640 x 480 pixels. Pediatric wide-field fundus photograph.
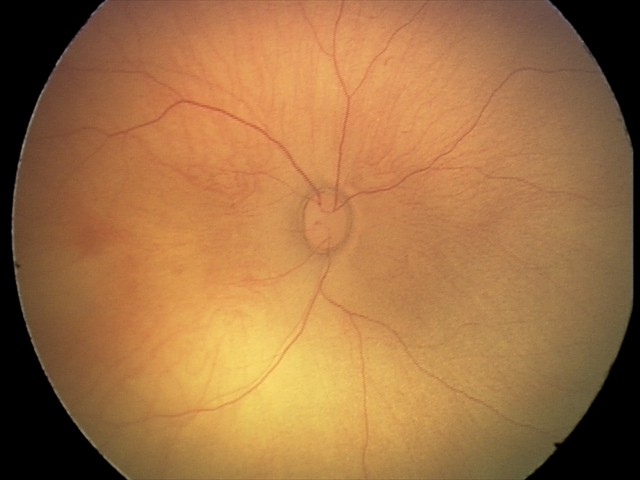
Diagnosis from this screening exam: retinal hemorrhages.